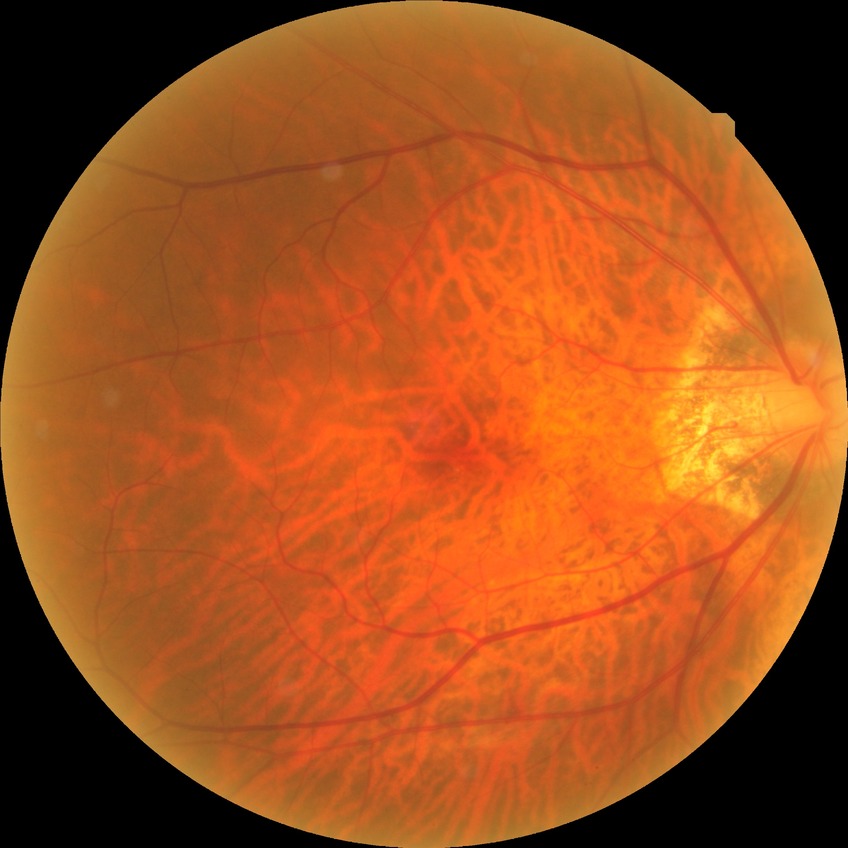

Diabetic retinopathy grade is no diabetic retinopathy.